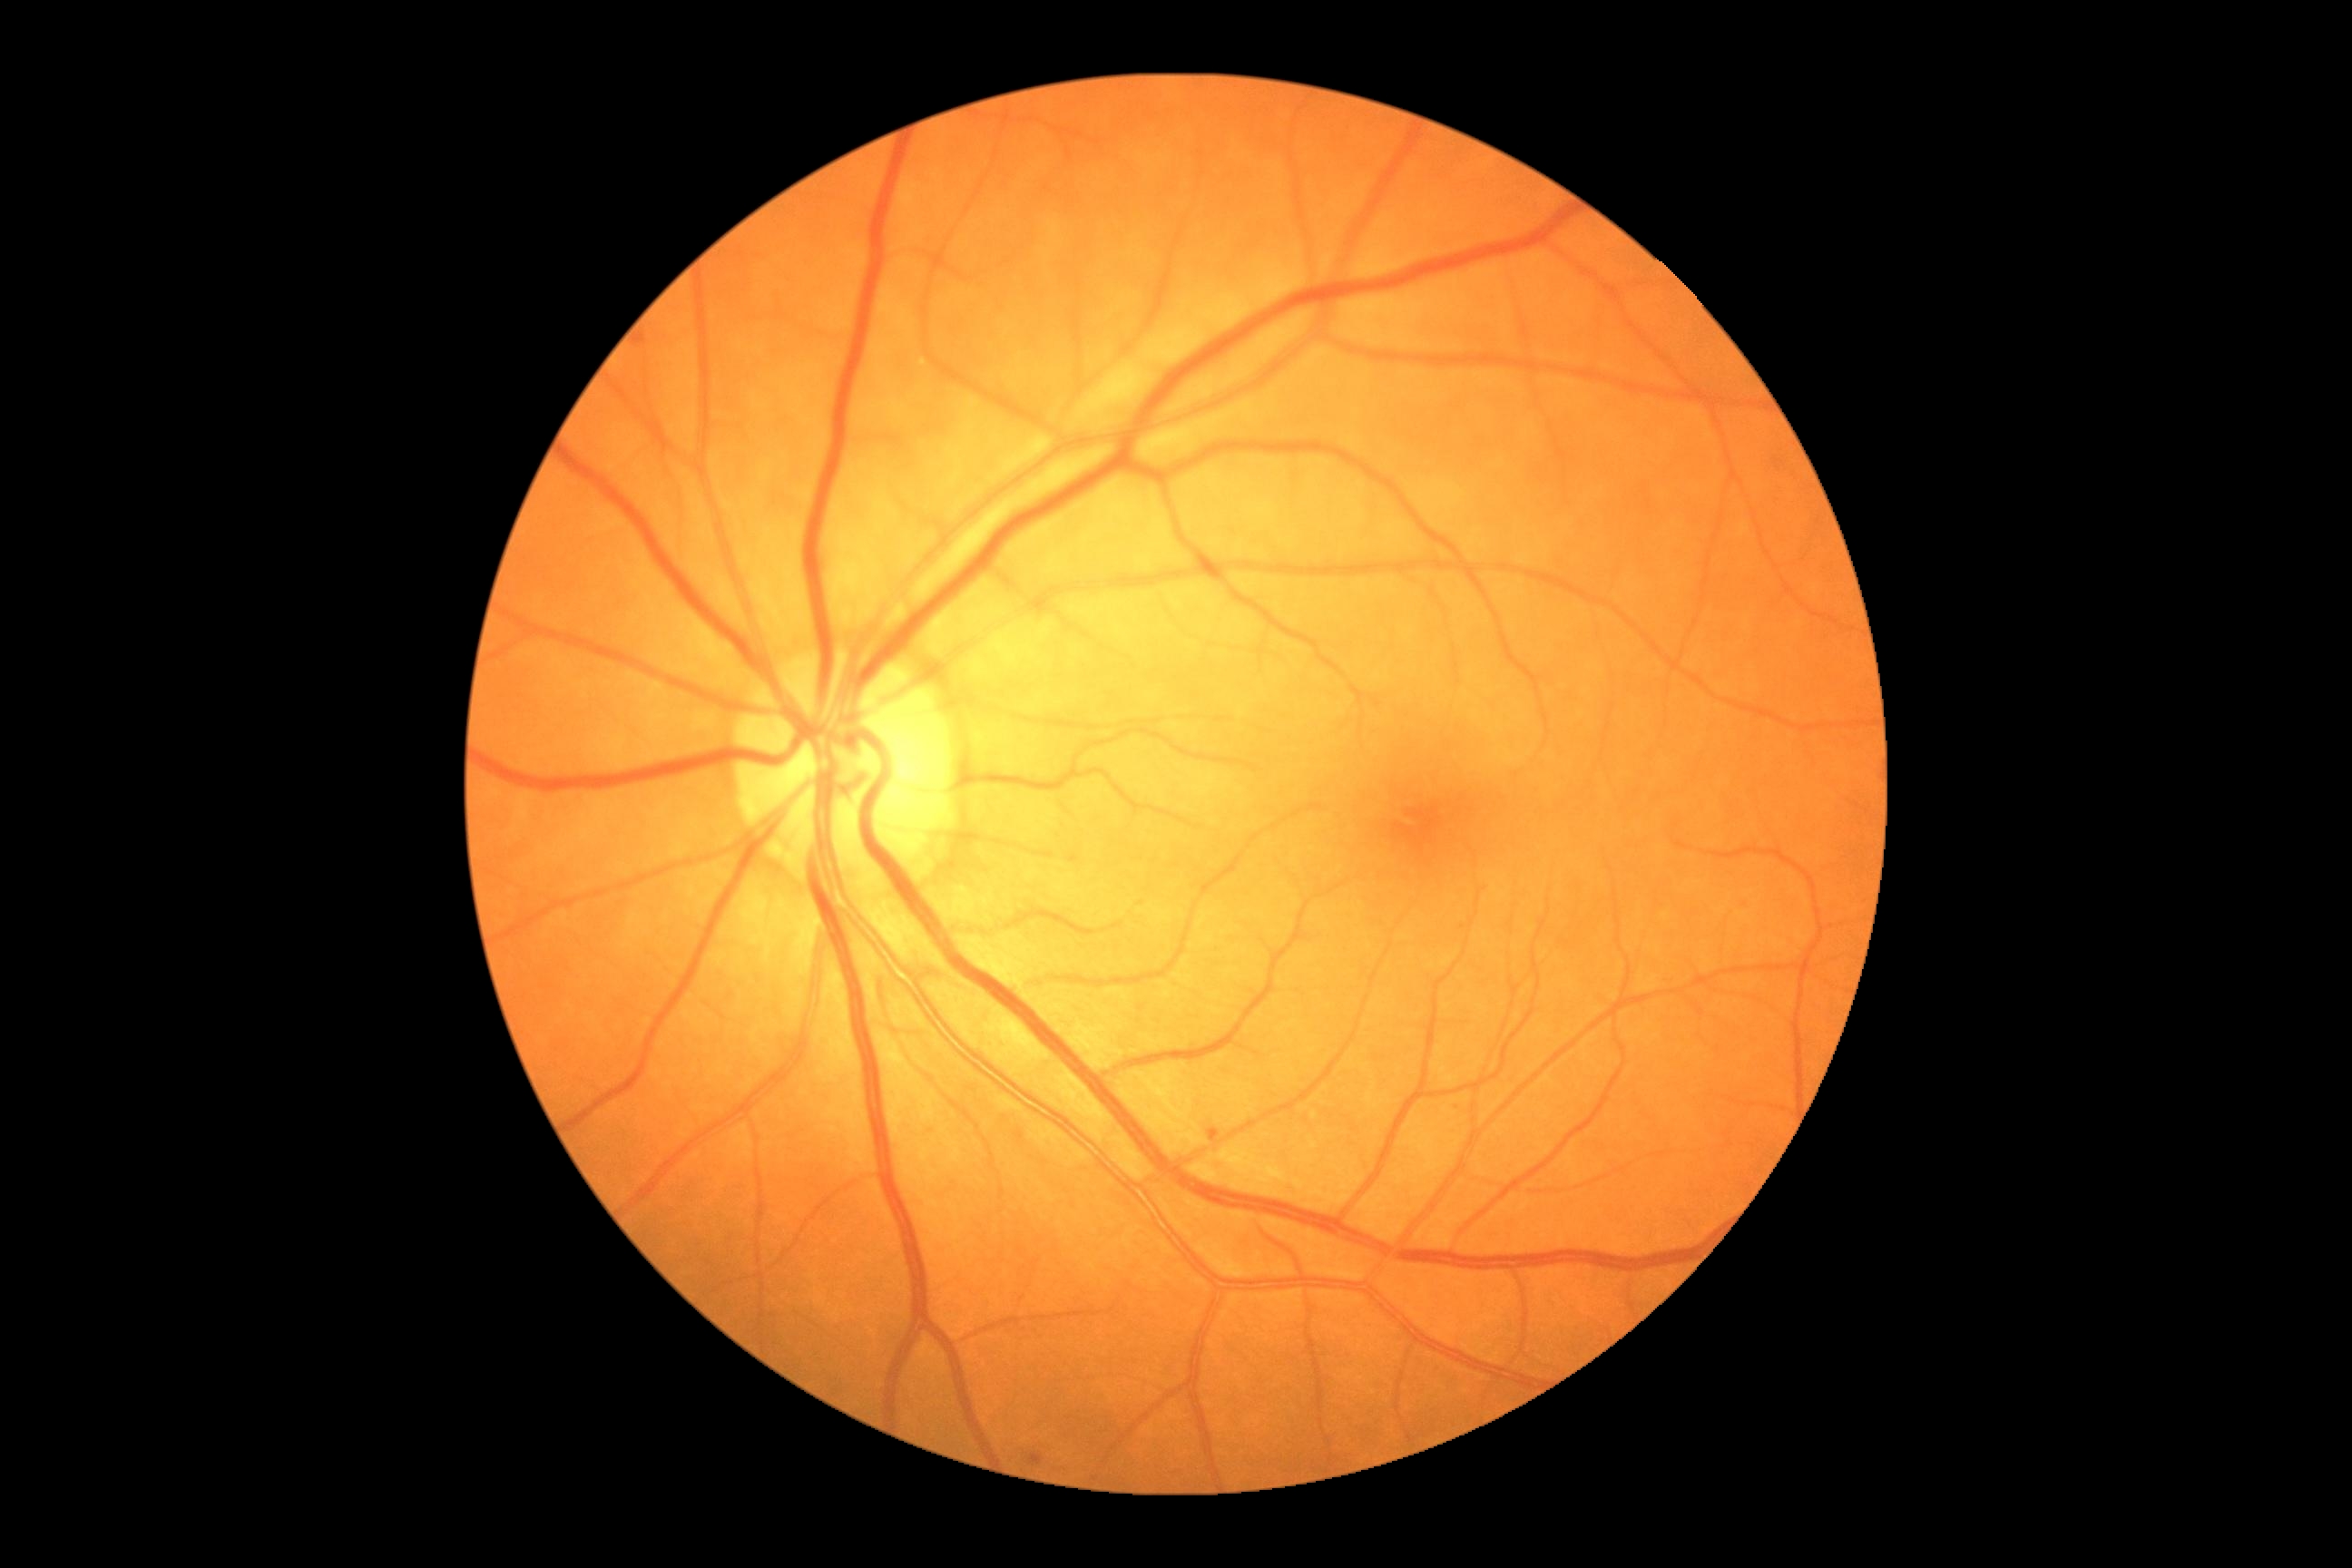

Diabetic retinopathy severity: mild NPDR (grade 1).
The retinopathy is classified as non-proliferative diabetic retinopathy.